Wide-field fundus image from infant ROP screening. 1240 by 1240 pixels. Camera: Phoenix ICON (100° FOV) — 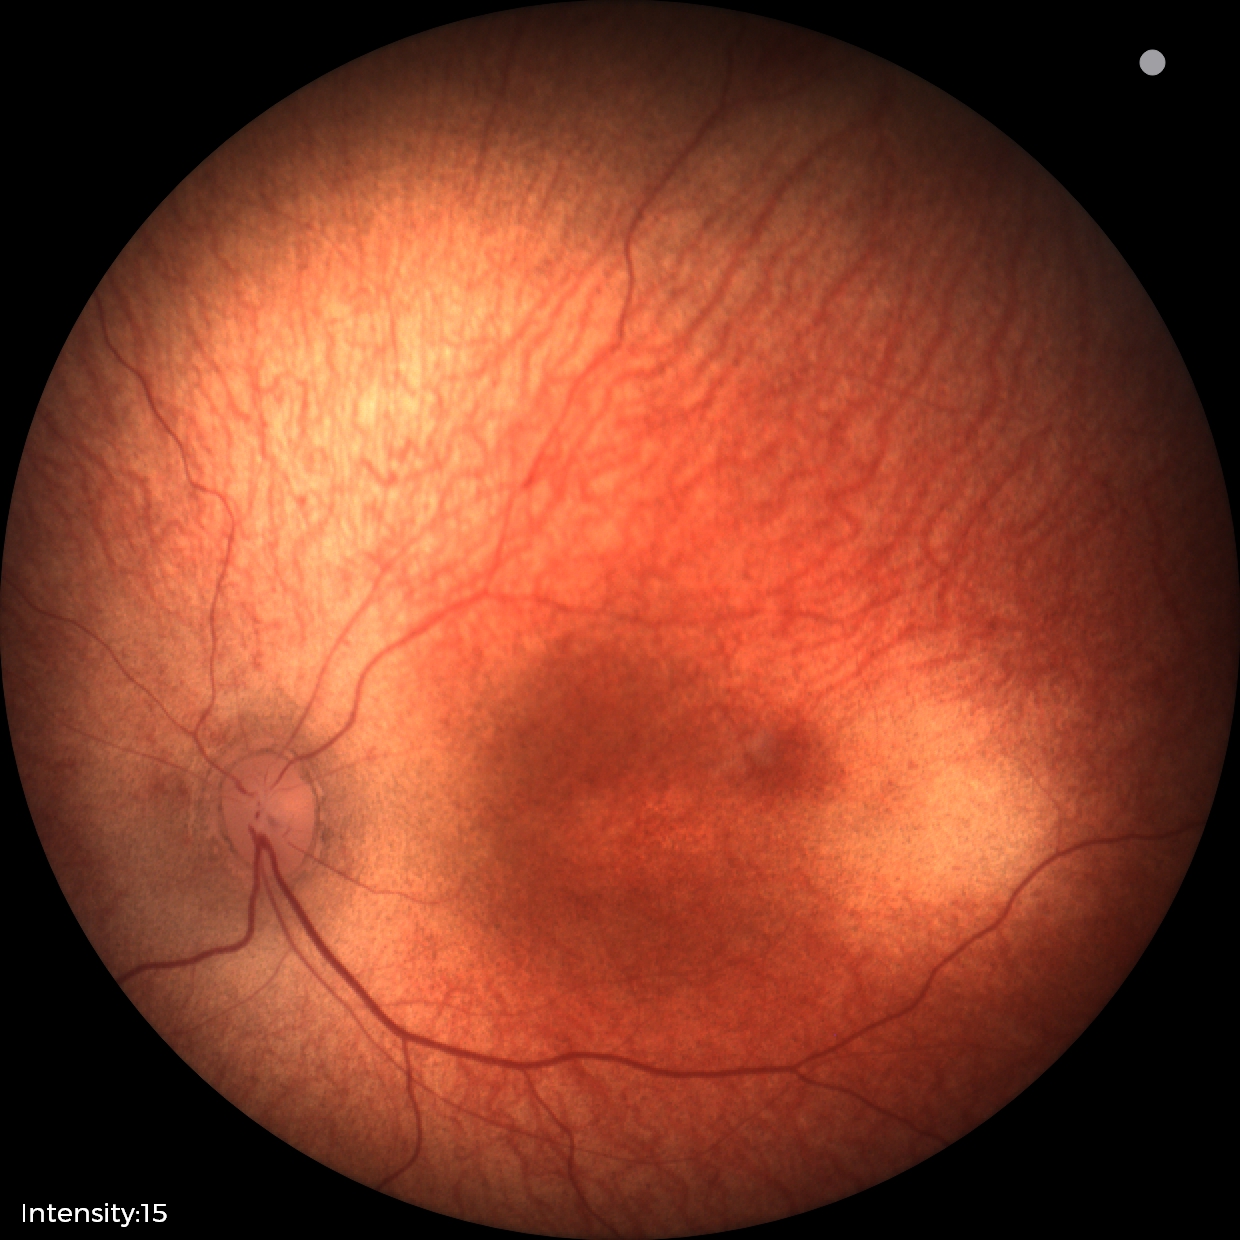
Examination with physiological retinal findings.